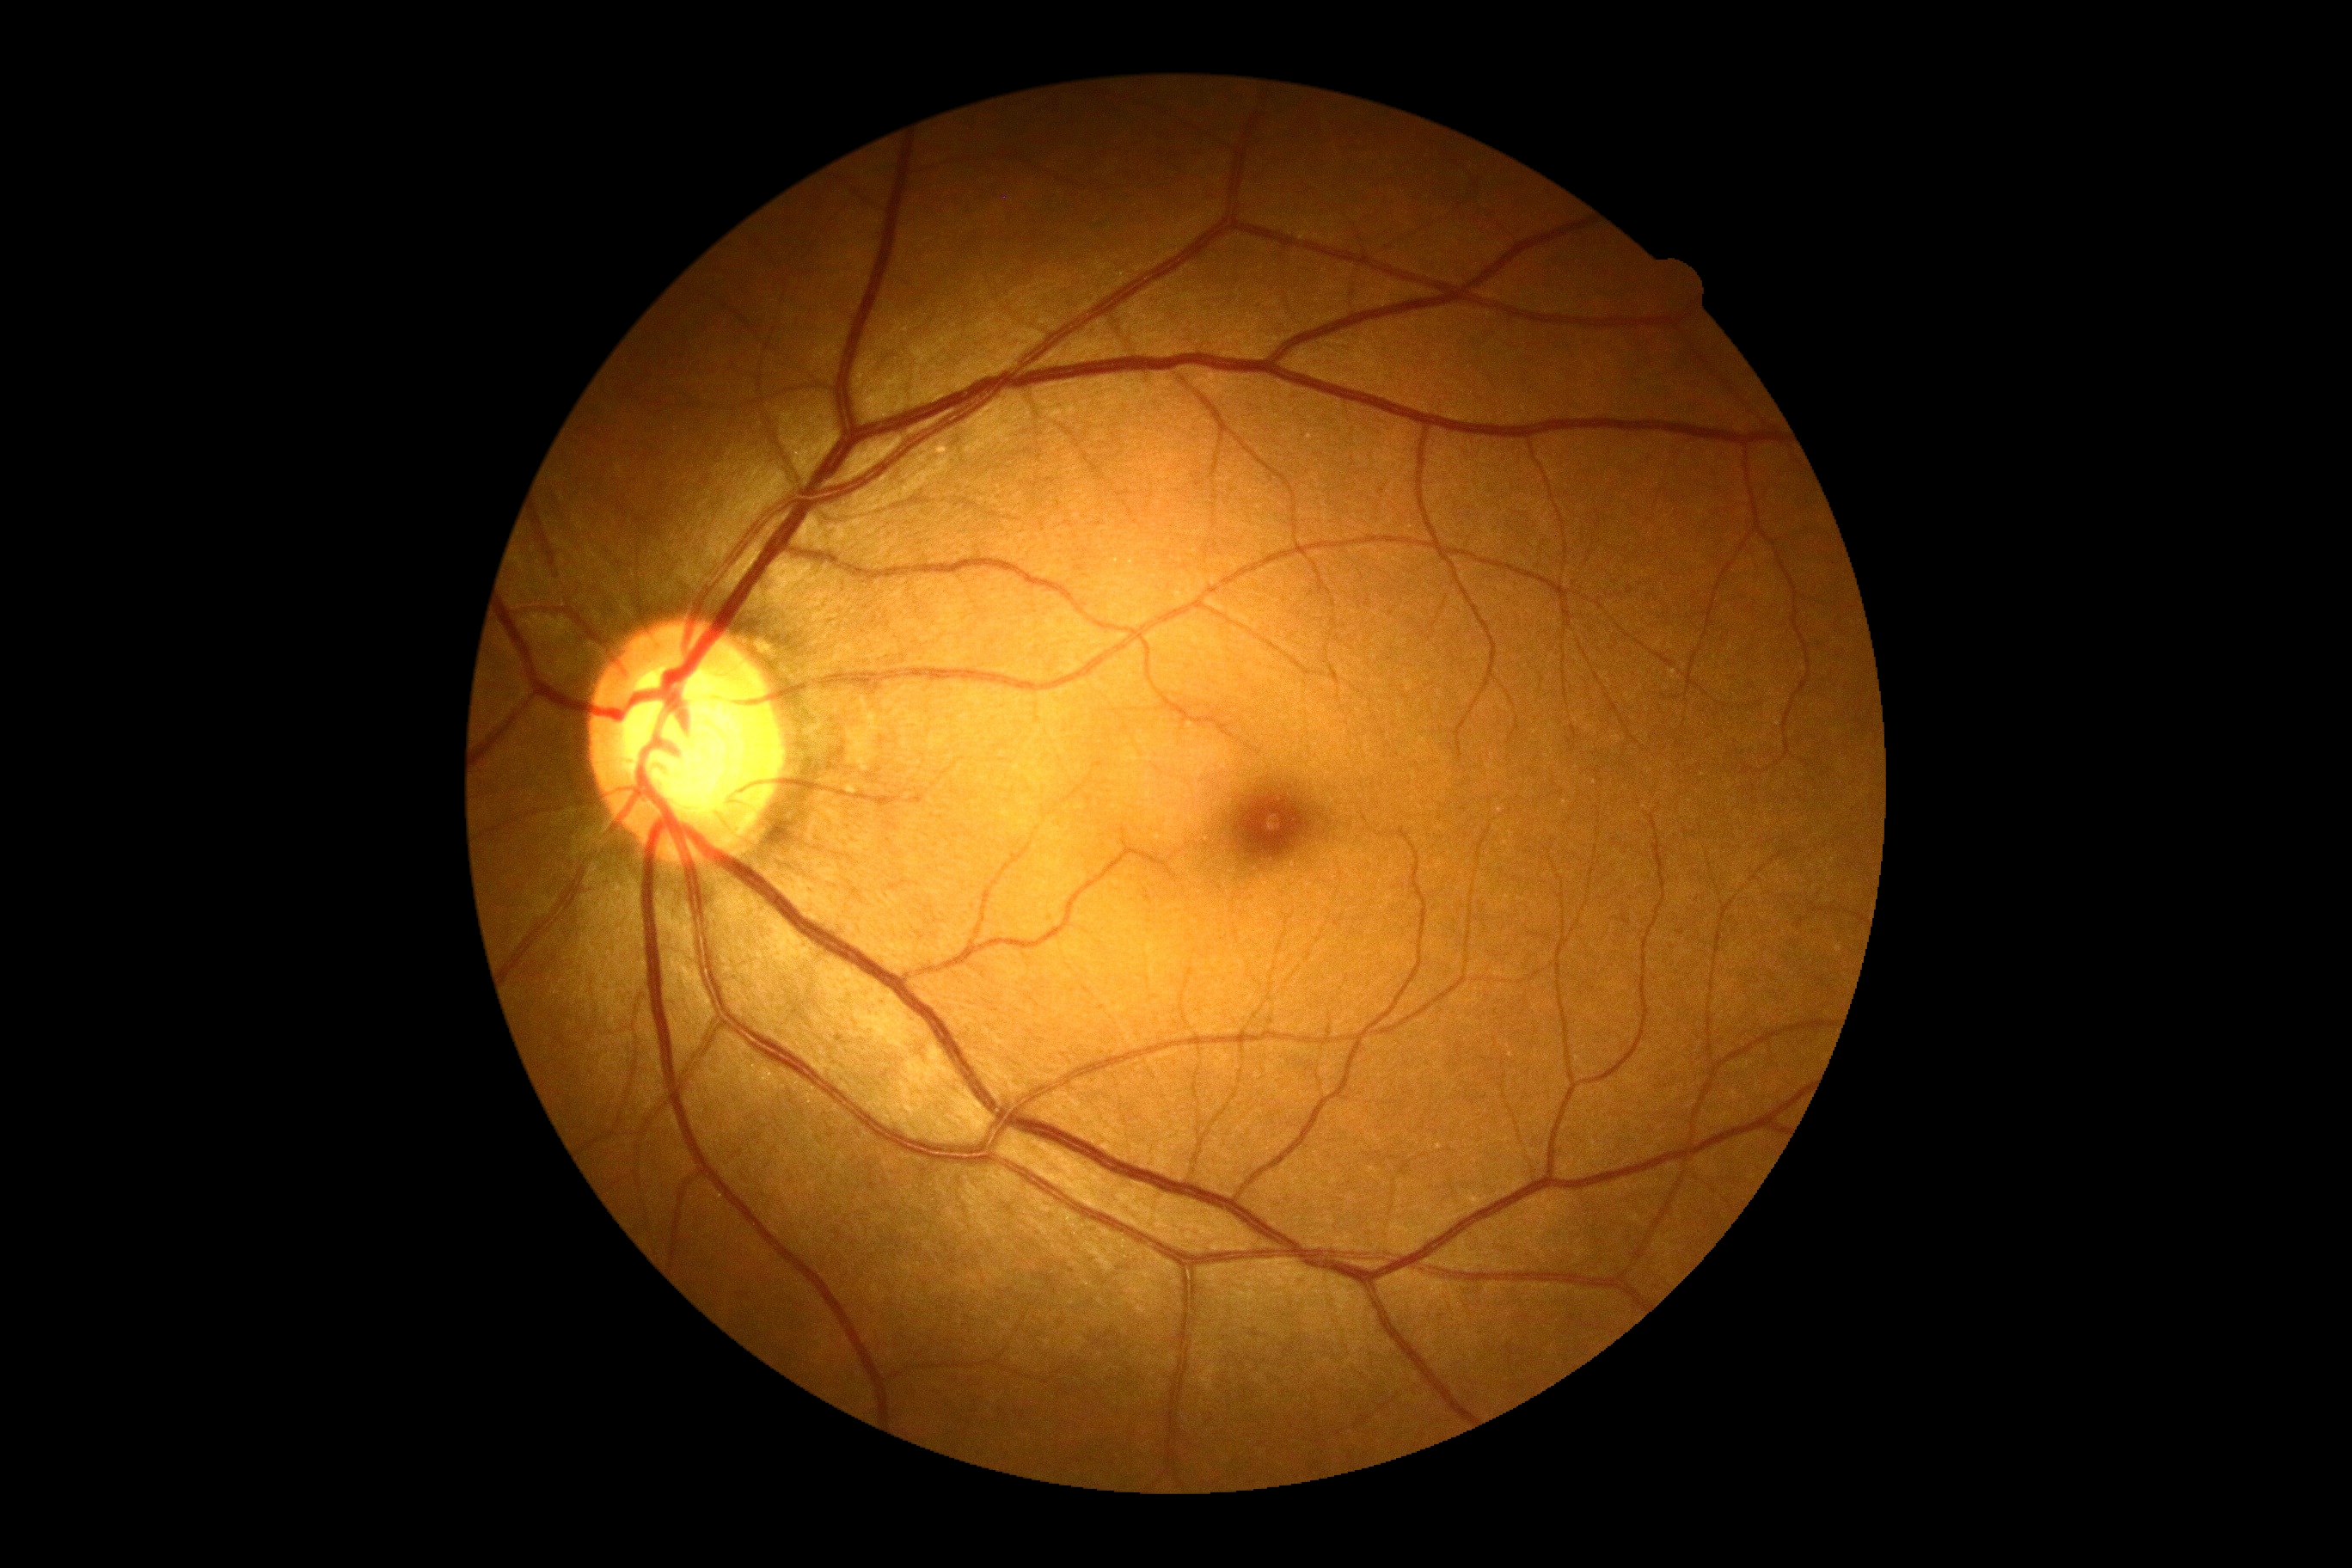
DR: grade 0 (no apparent retinopathy).
No diabetic retinal disease findings.